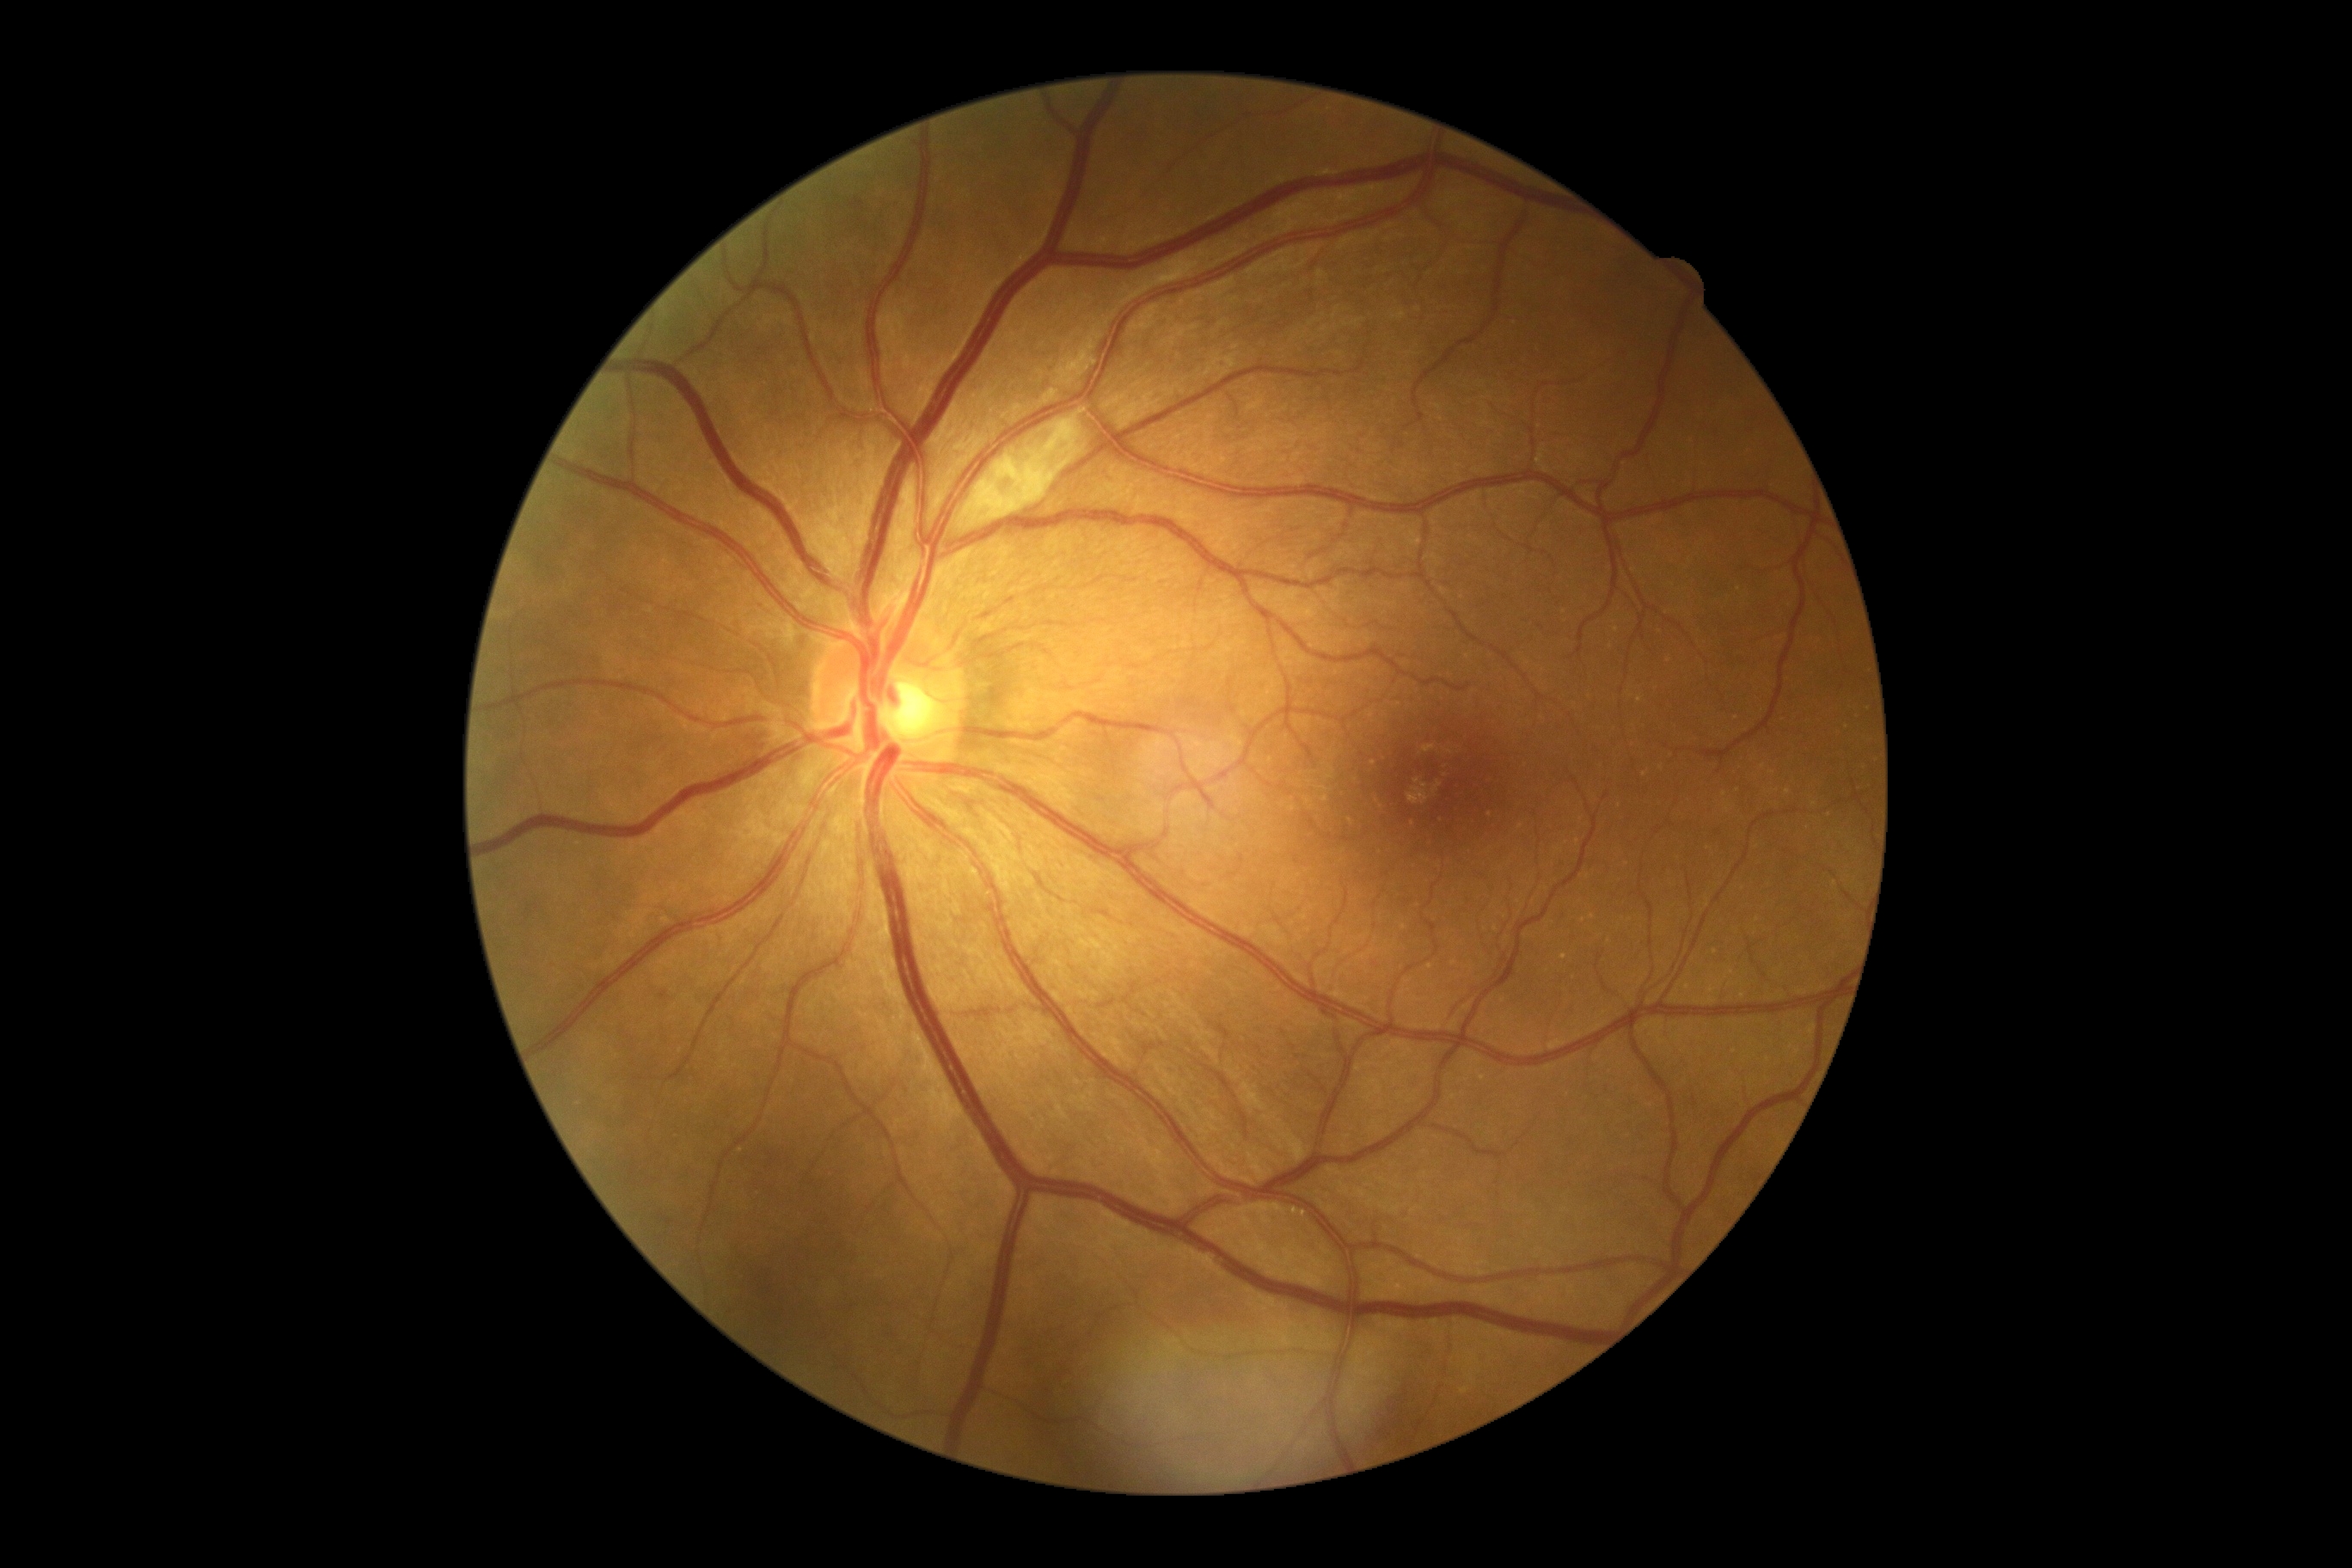

retinopathy: 2.